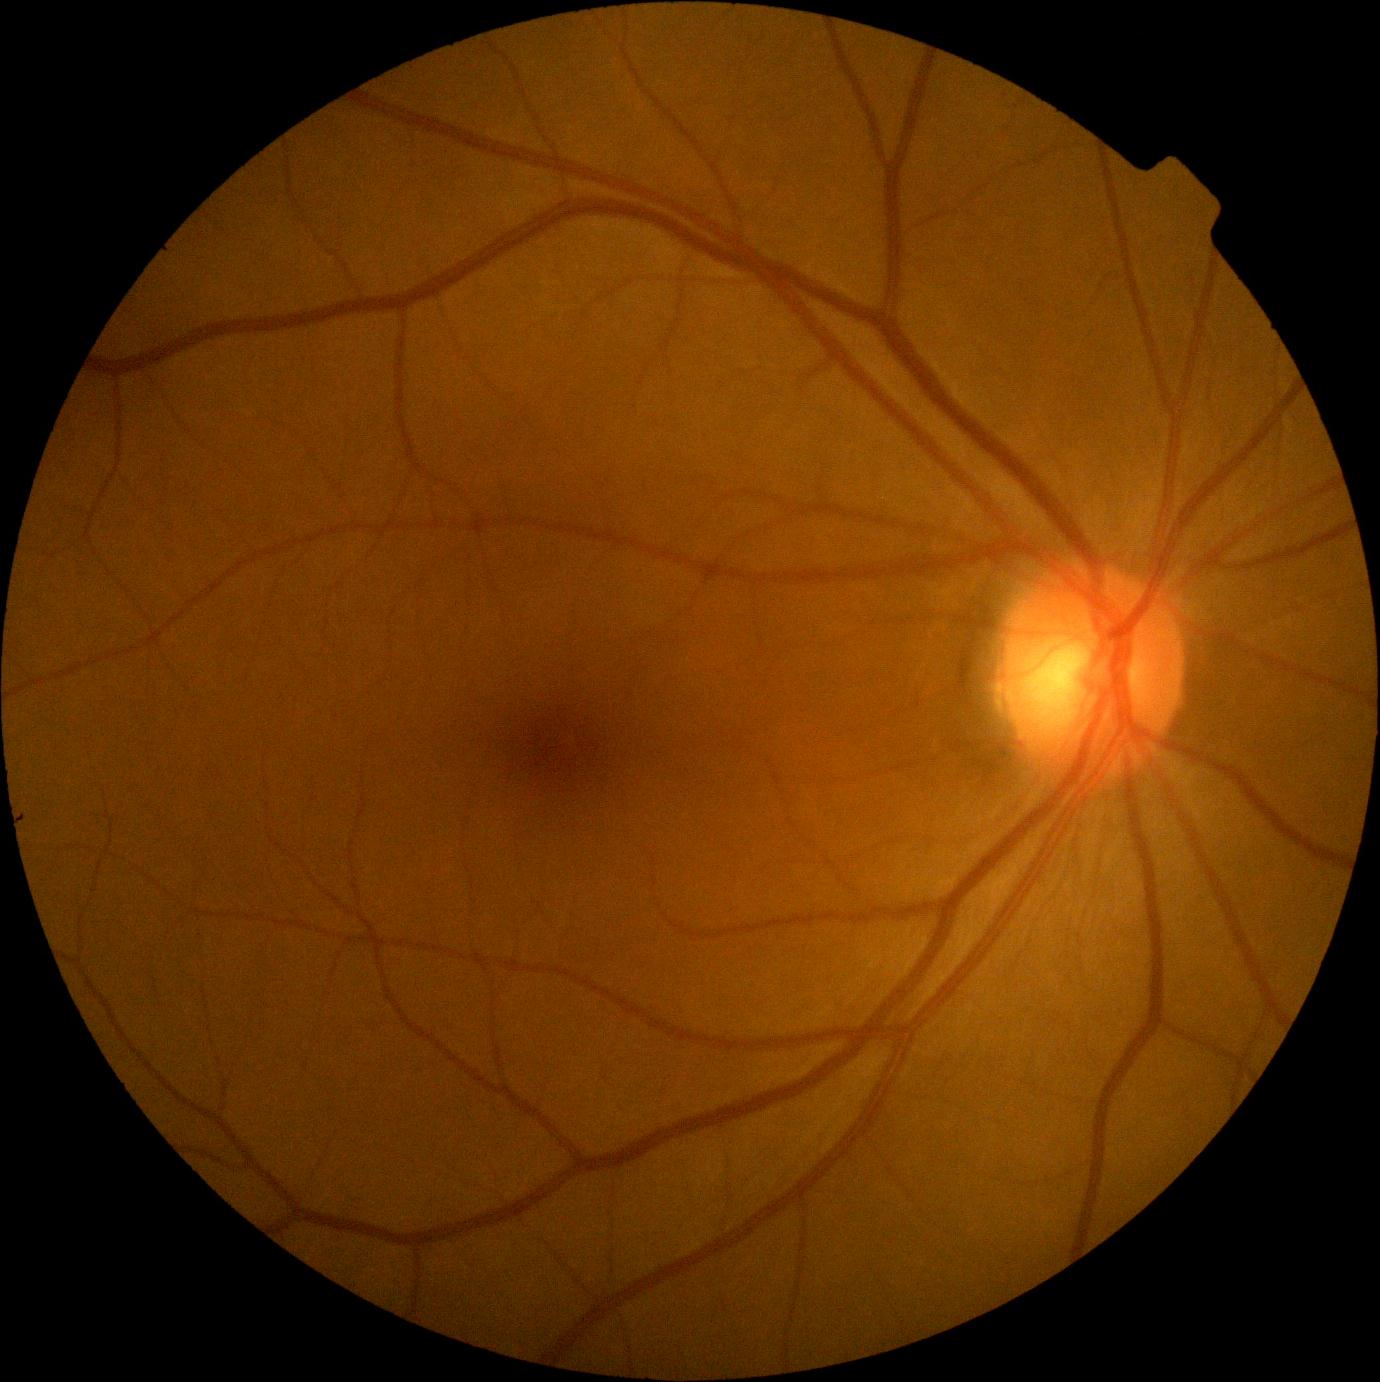 dr_impression: no DR findings
dr_grade: no apparent retinopathy (0)